Acquired with a NIDEK AFC-230. 45-degree field of view. Posterior pole color fundus photograph.
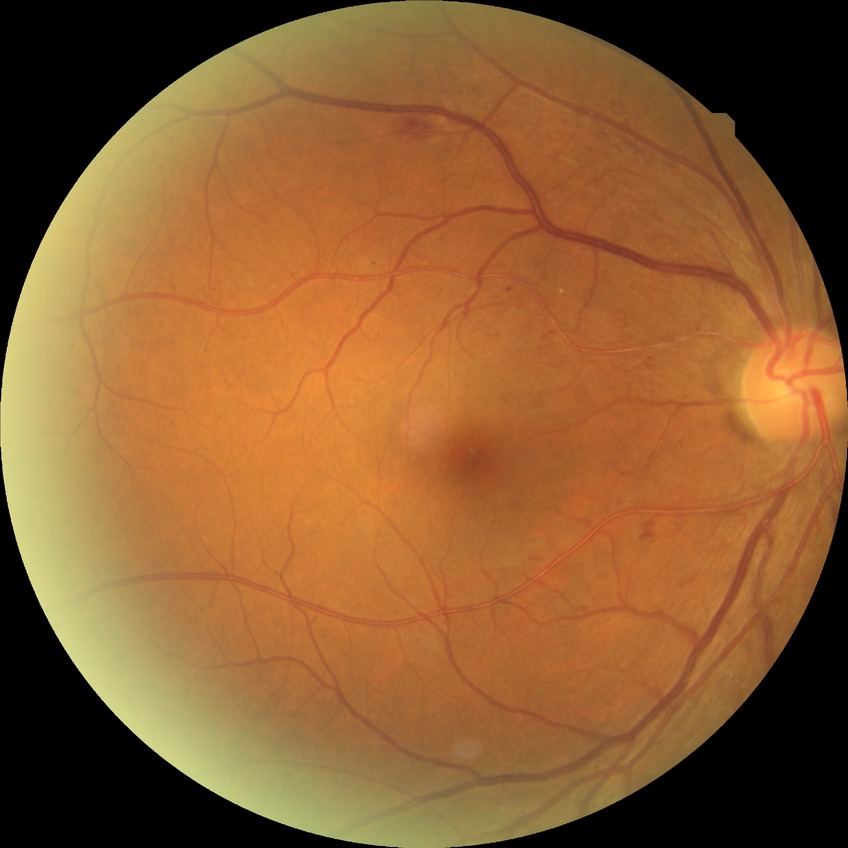

diabetic retinopathy (DR)=SDR (simple diabetic retinopathy).